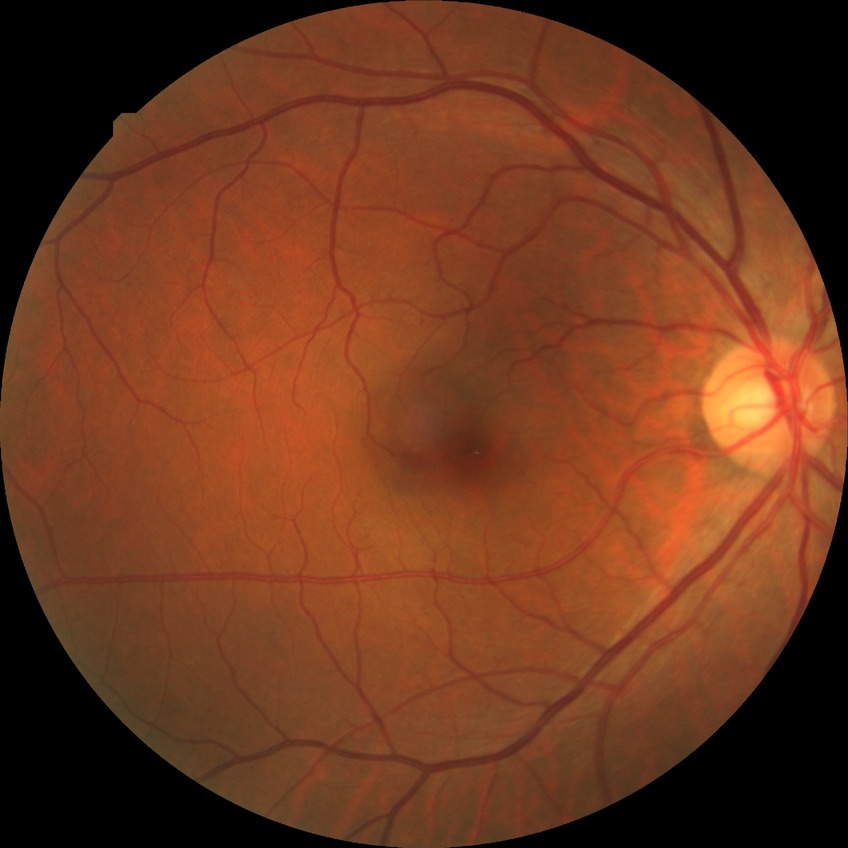
diabetic retinopathy (DR): SDR (simple diabetic retinopathy).